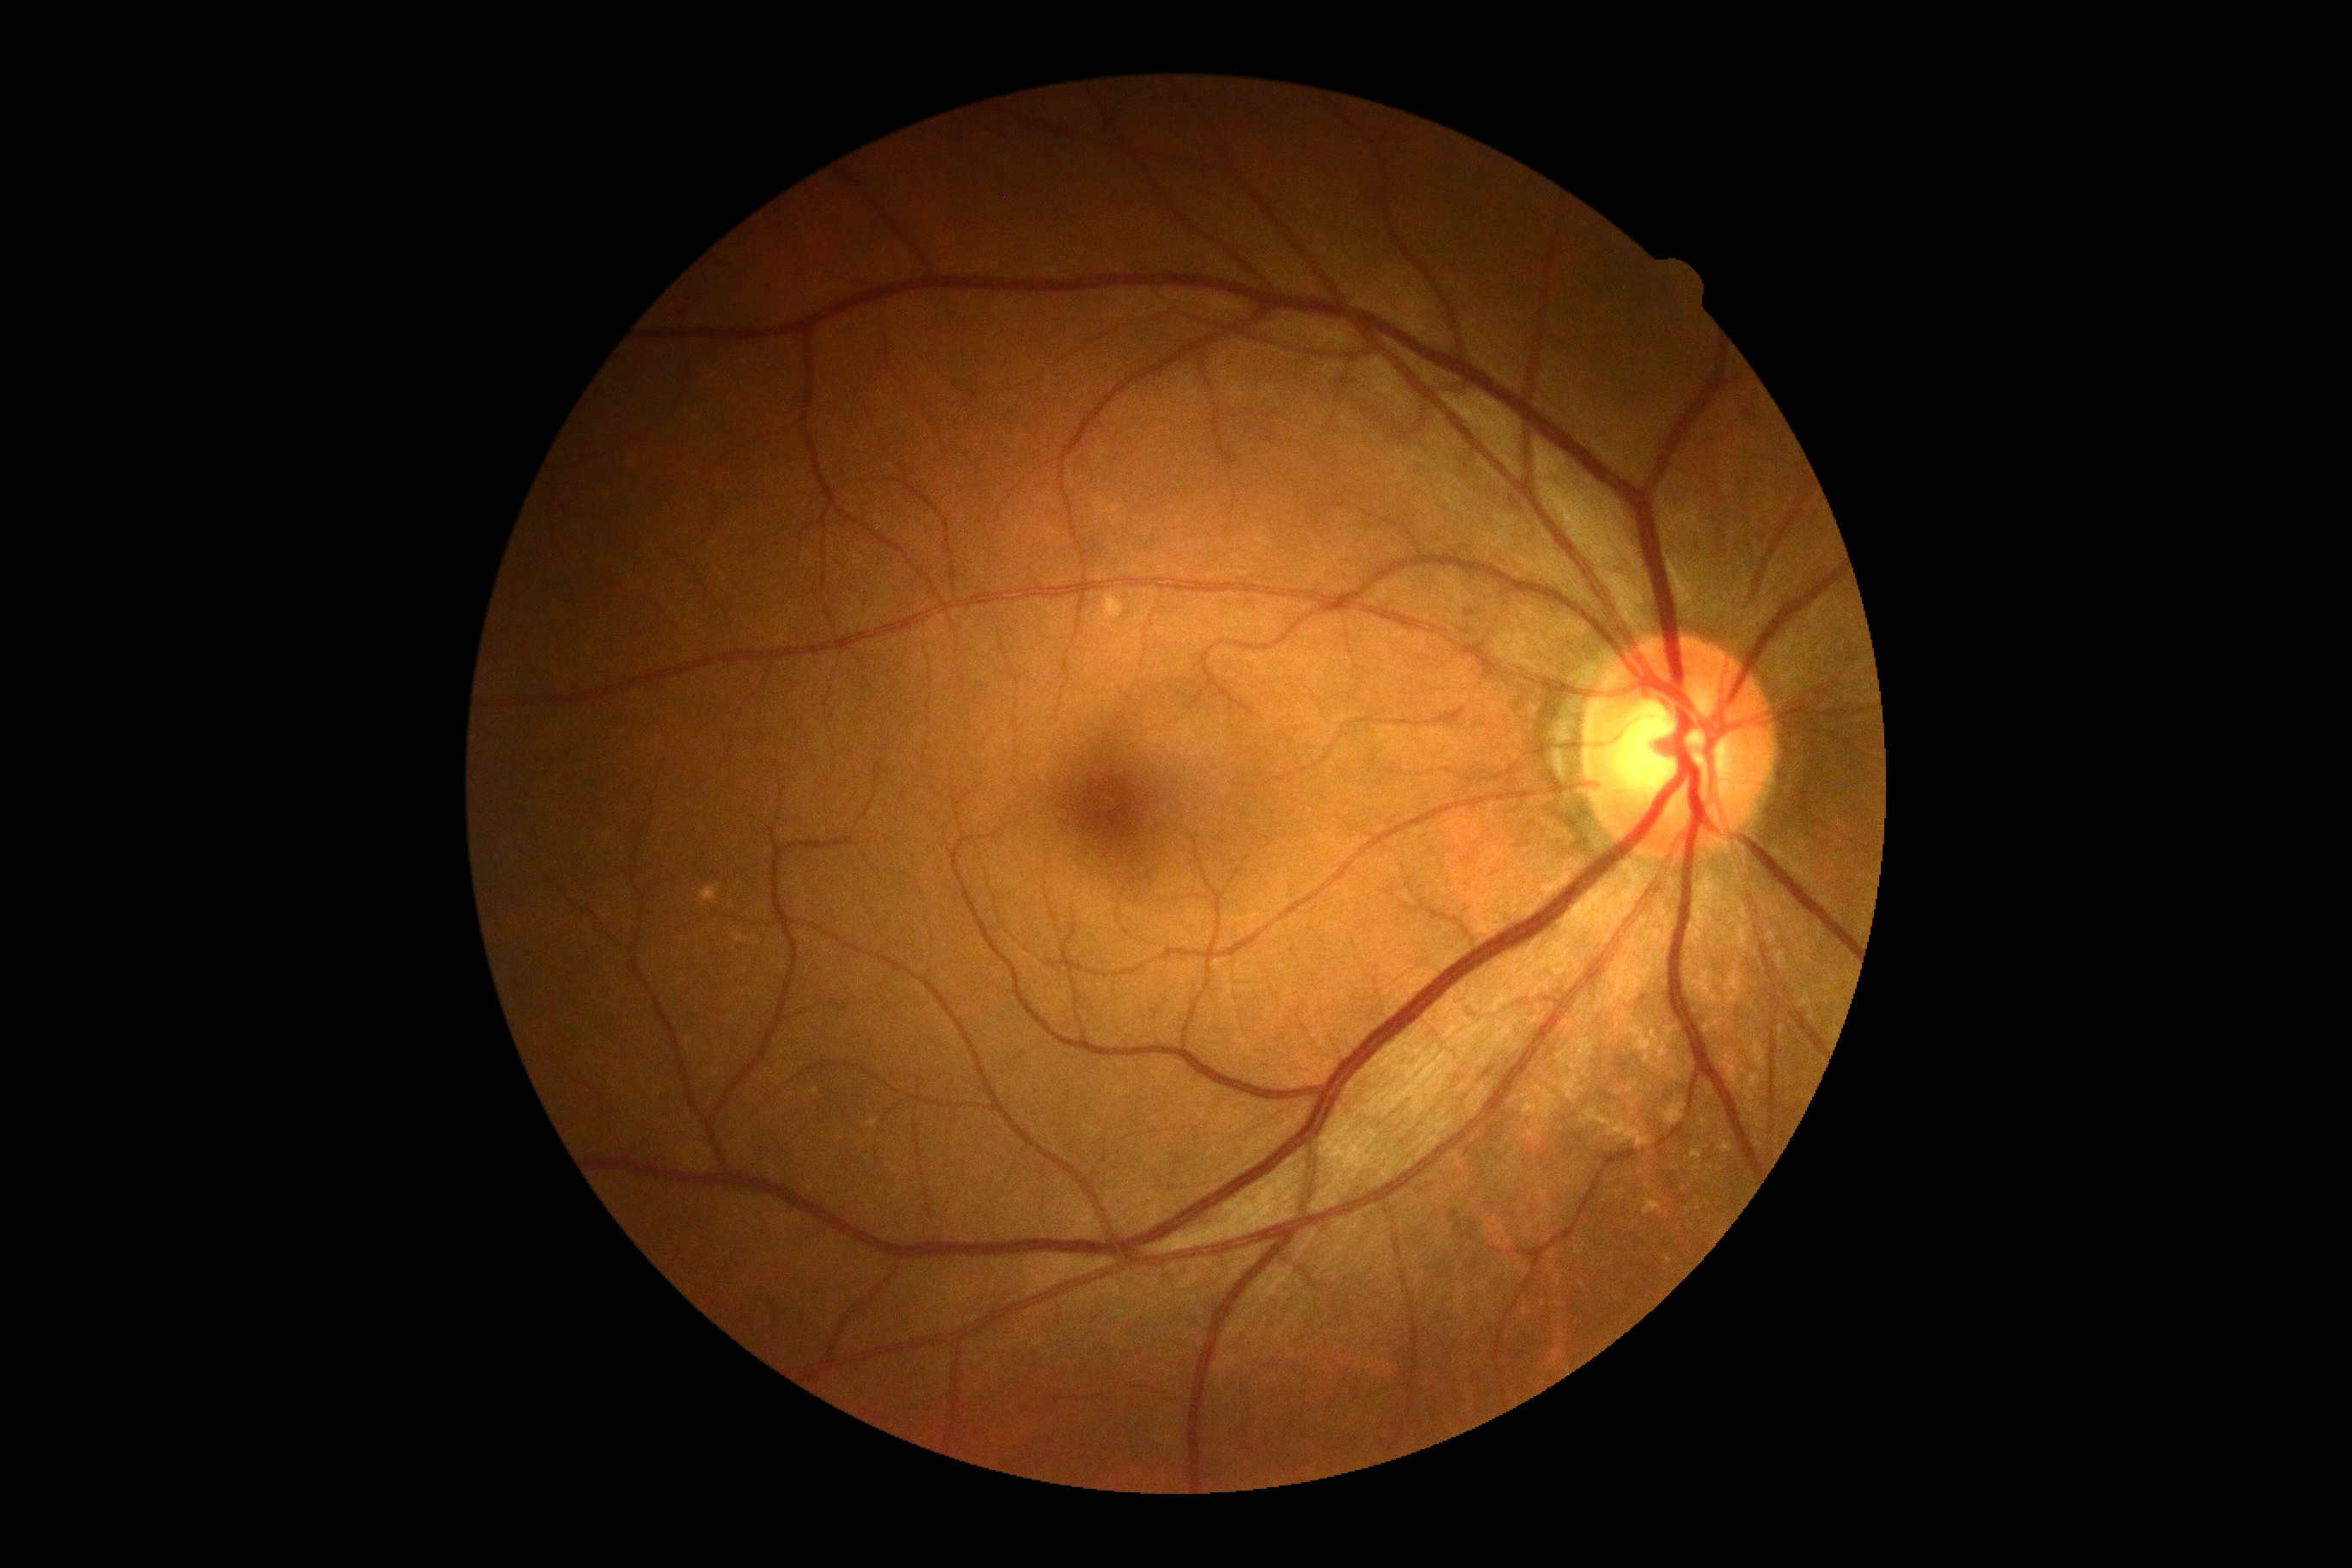 Diabetic retinopathy severity is grade 0 (no apparent retinopathy). No apparent diabetic retinopathy.